Fundus photo: 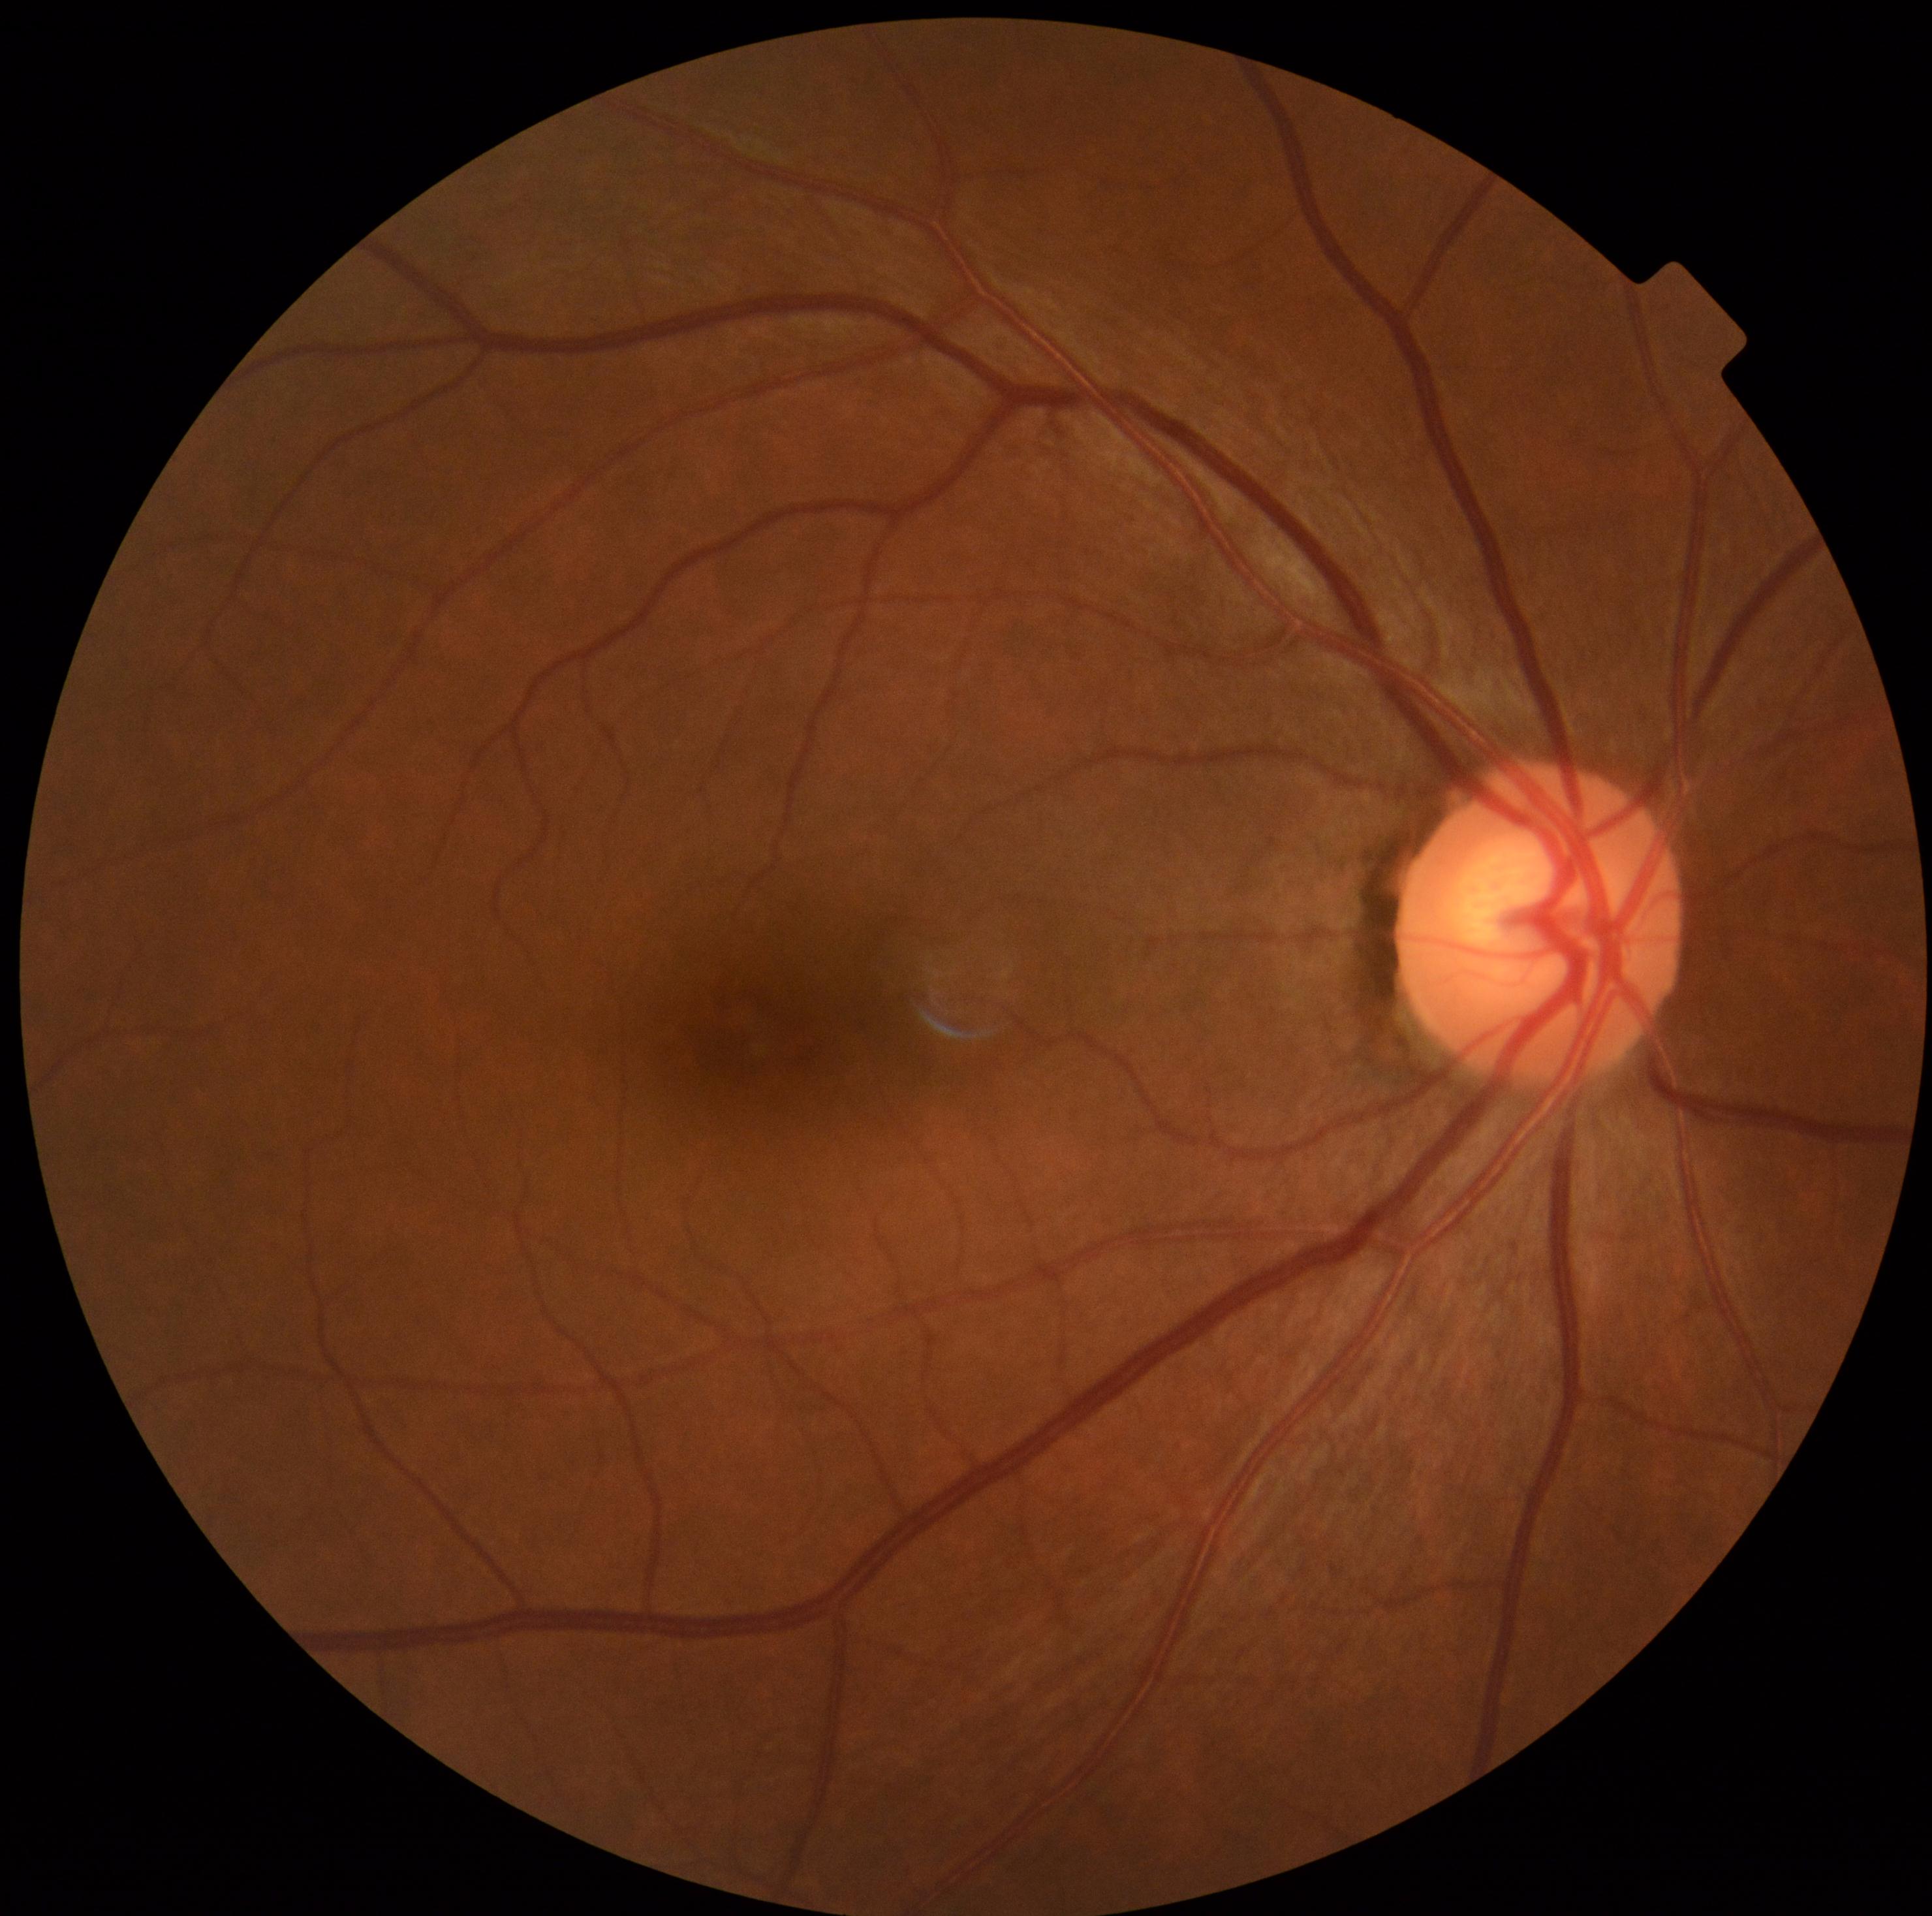

Diabetic retinopathy (DR): no apparent diabetic retinopathy (grade 0).